640x480; wide-field fundus photograph of an infant.
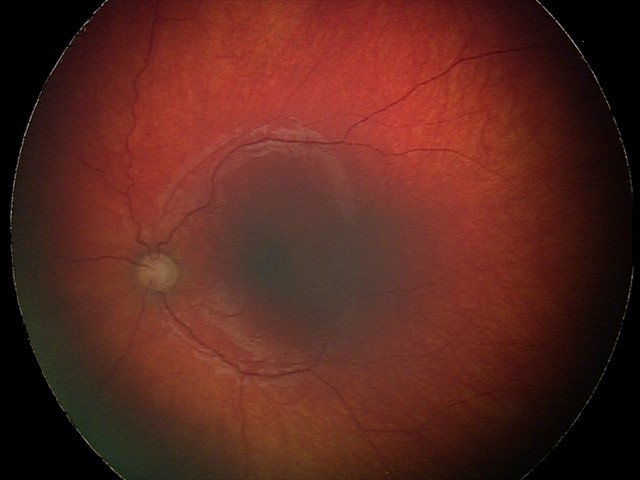
Q: What is the diagnosis from this examination?
A: optic nerve hypoplasia